45° FOV · fundus photo · 2212x1659:
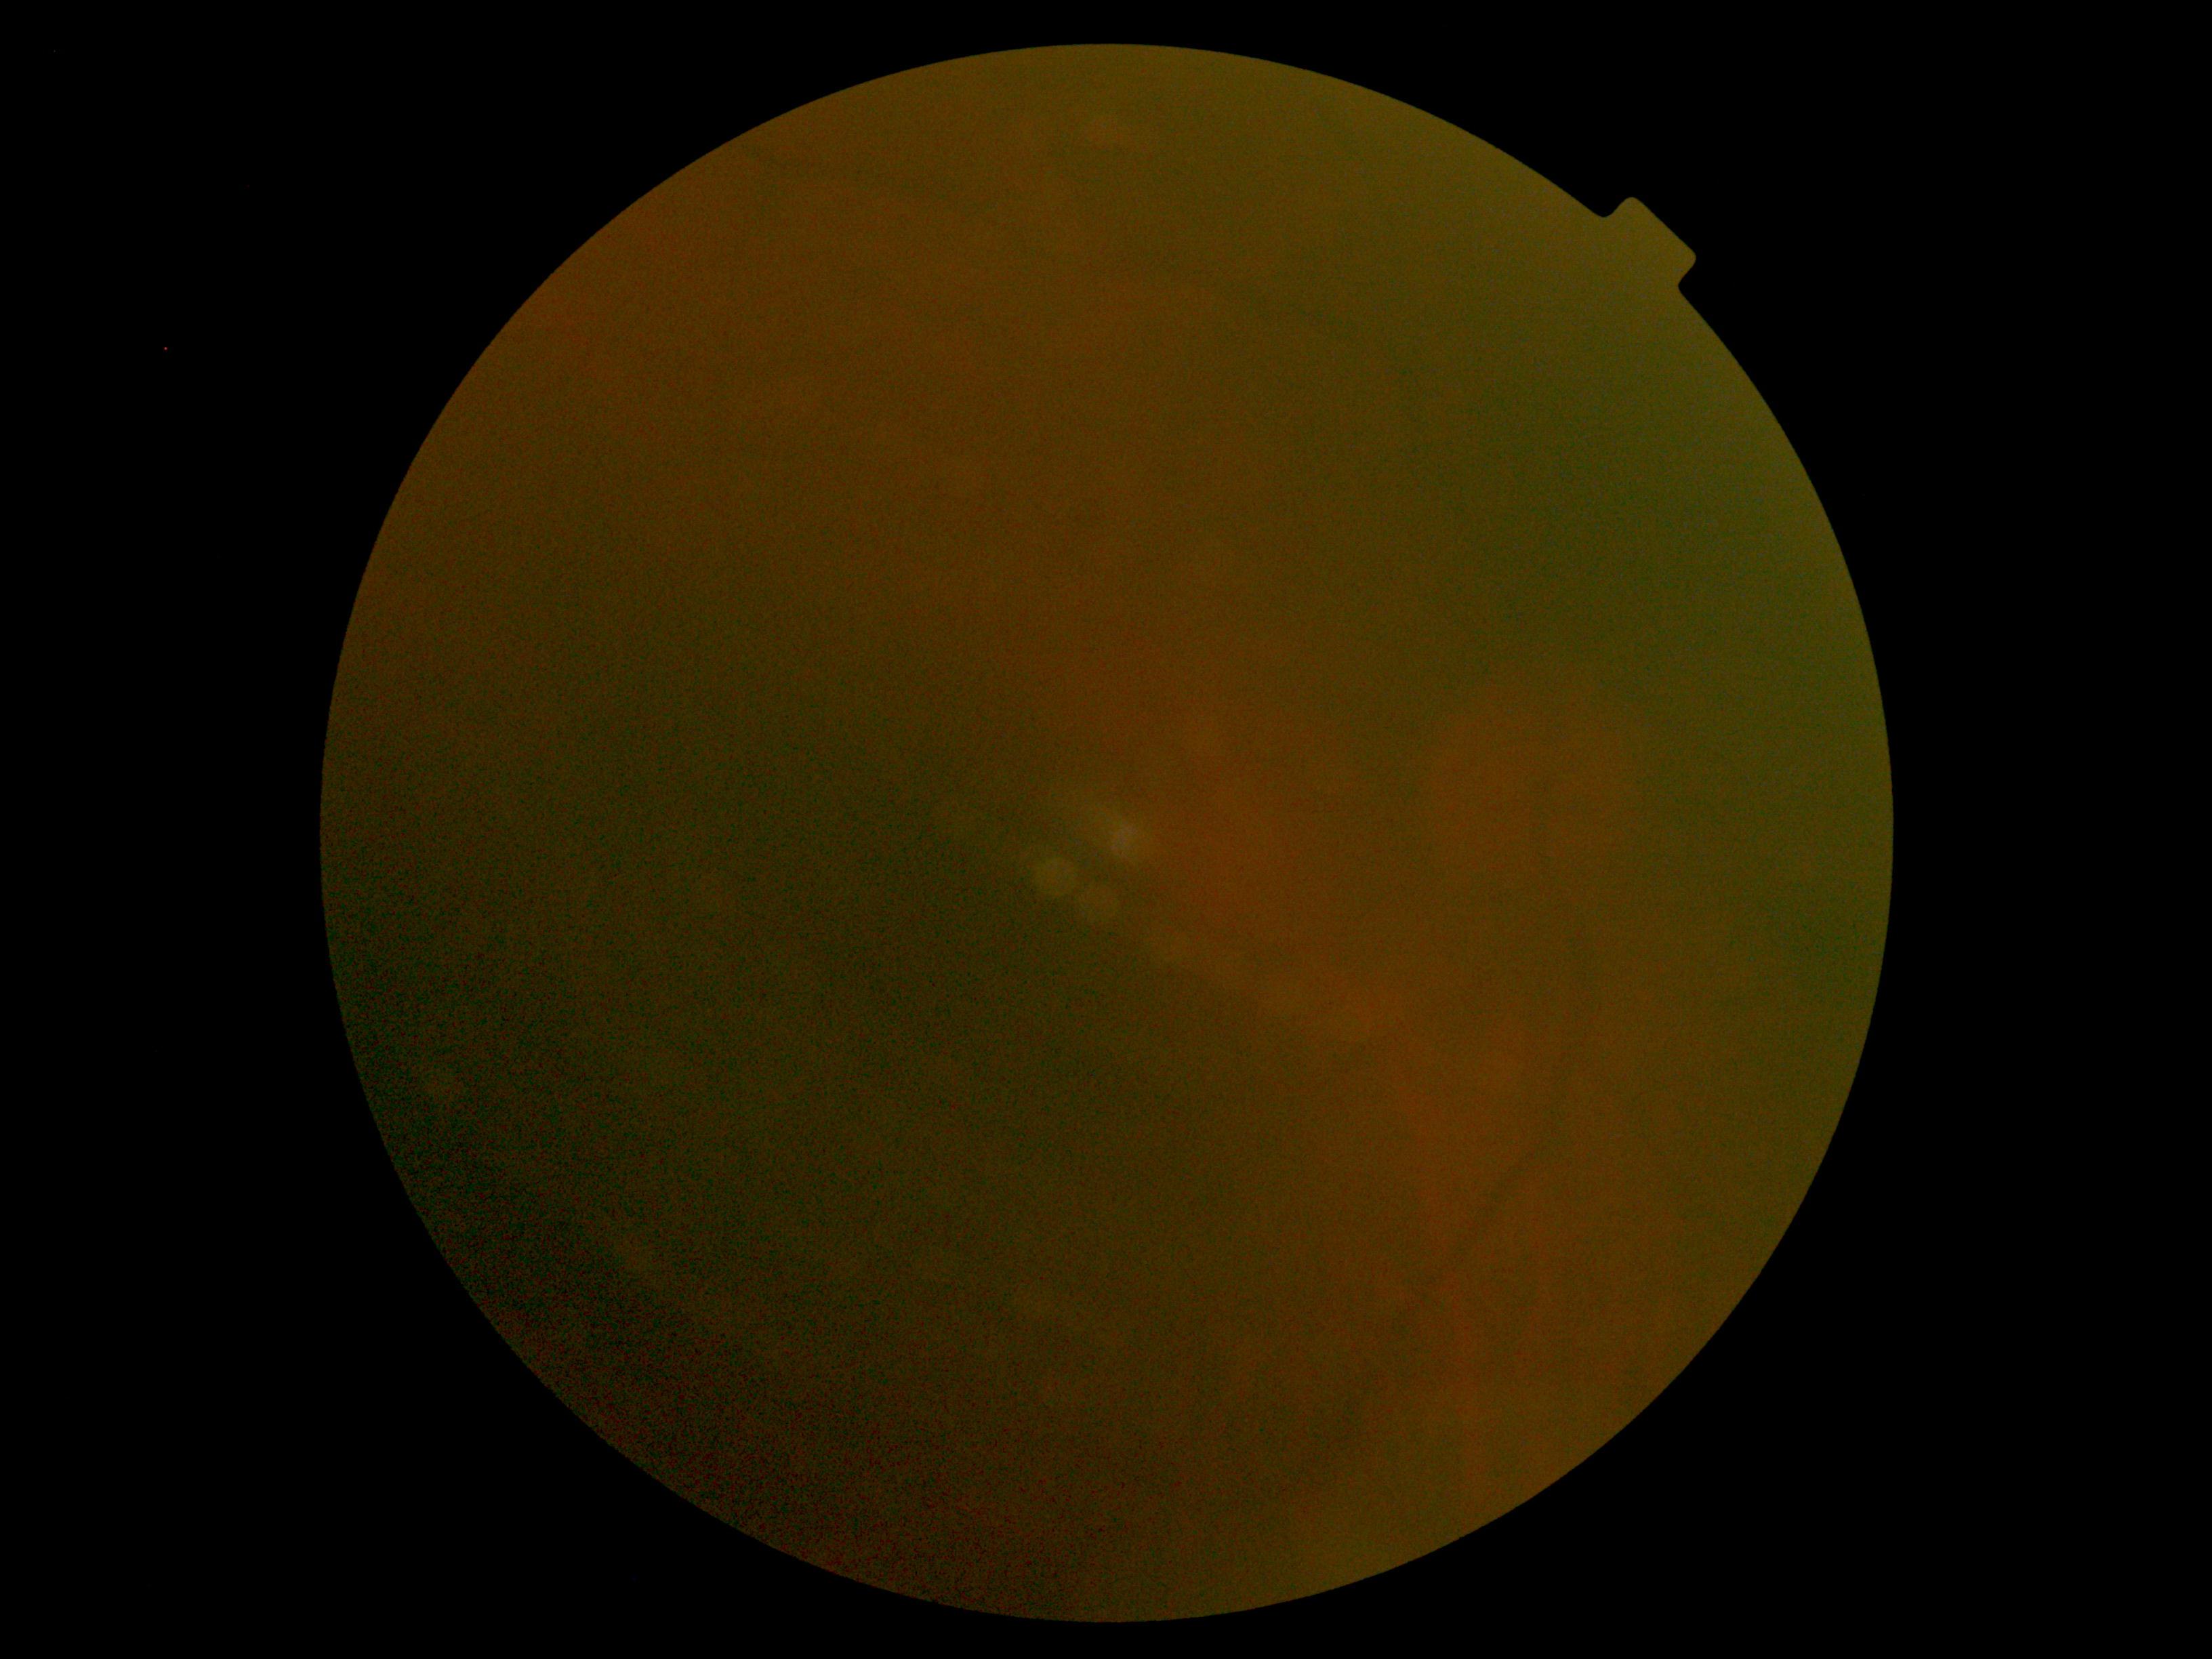
Retinopathy grade: ungradable due to poor image quality.